RetCam wide-field infant fundus image — 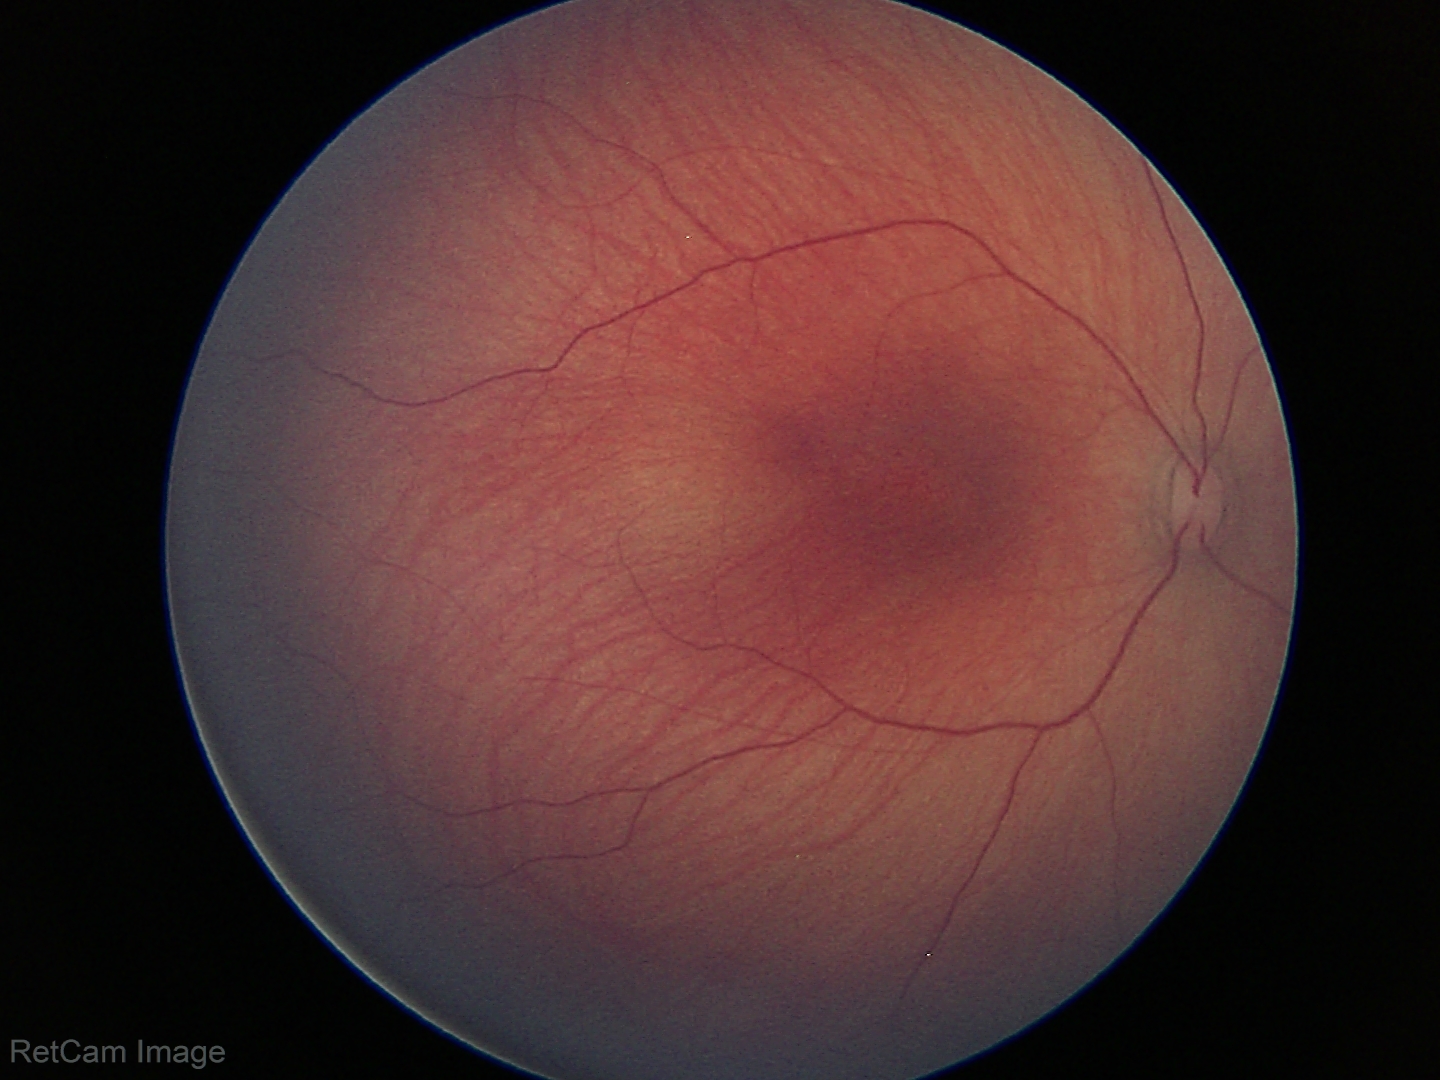
Q: What is the diagnosis from this examination?
A: no abnormal retinal findings